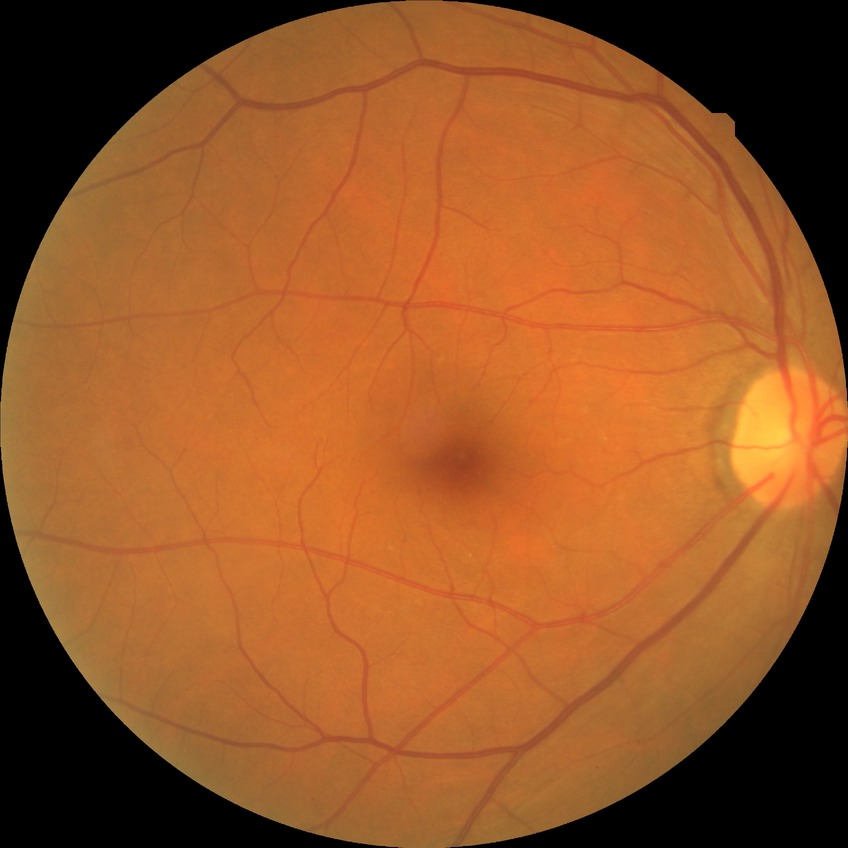 Findings:
– diabetic retinopathy grade — no diabetic retinopathy